Infant wide-field fundus photograph · 100° field of view (Phoenix ICON) · 1240 by 1240 pixels.
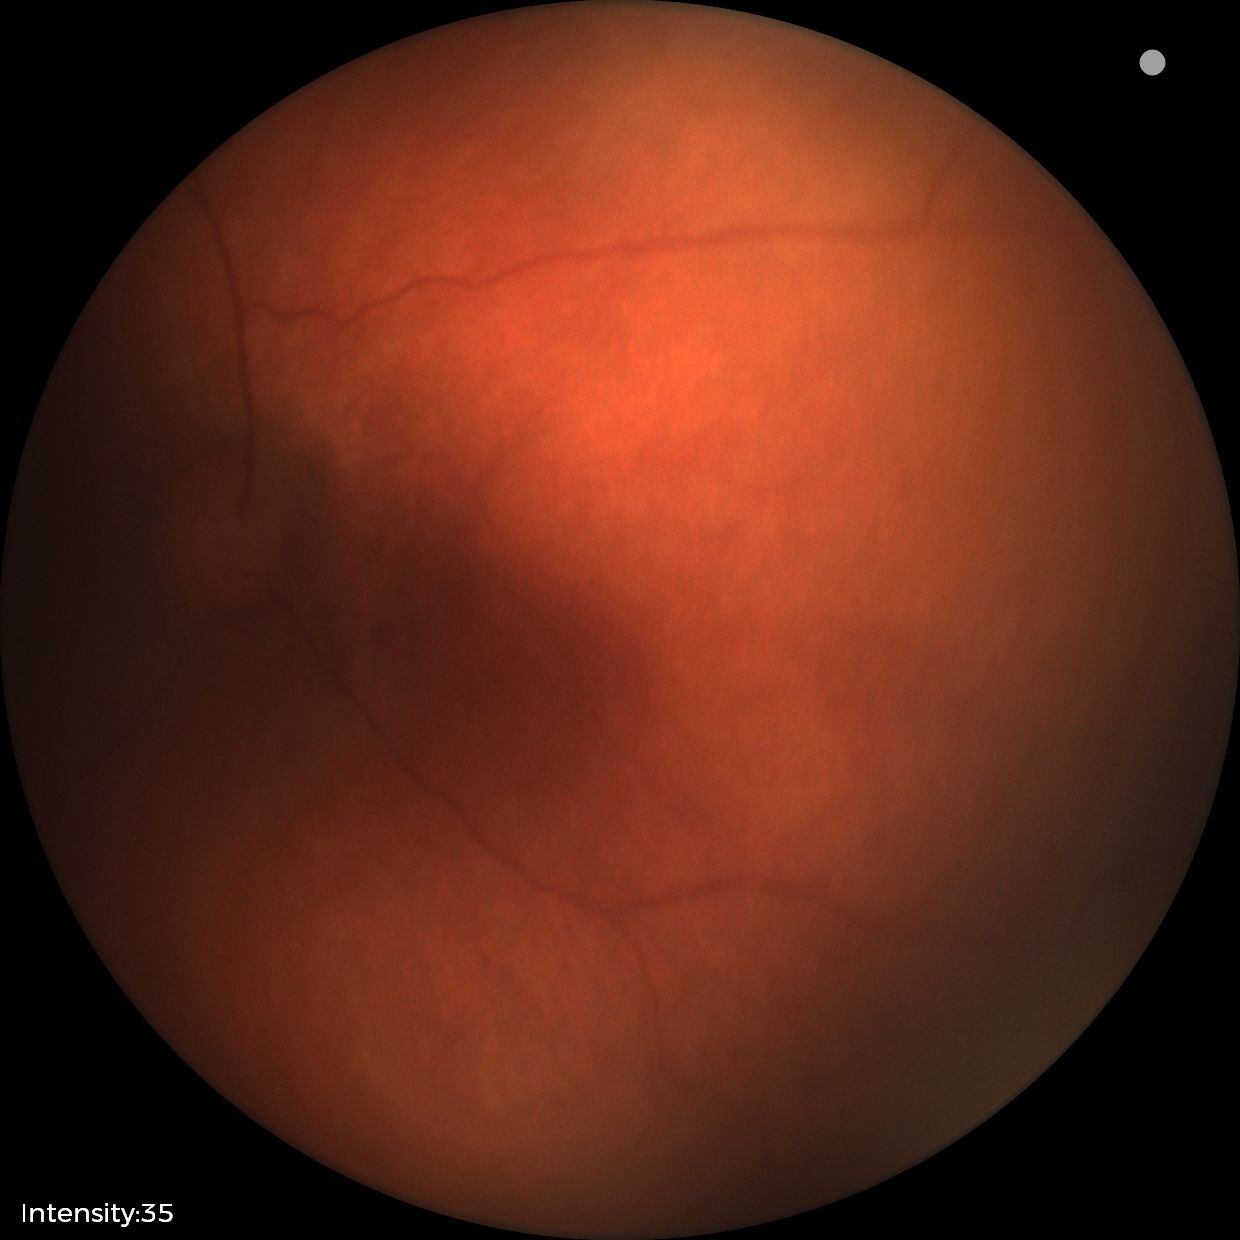 Q: What was the screening finding?
A: physiological appearance with no retinal pathology